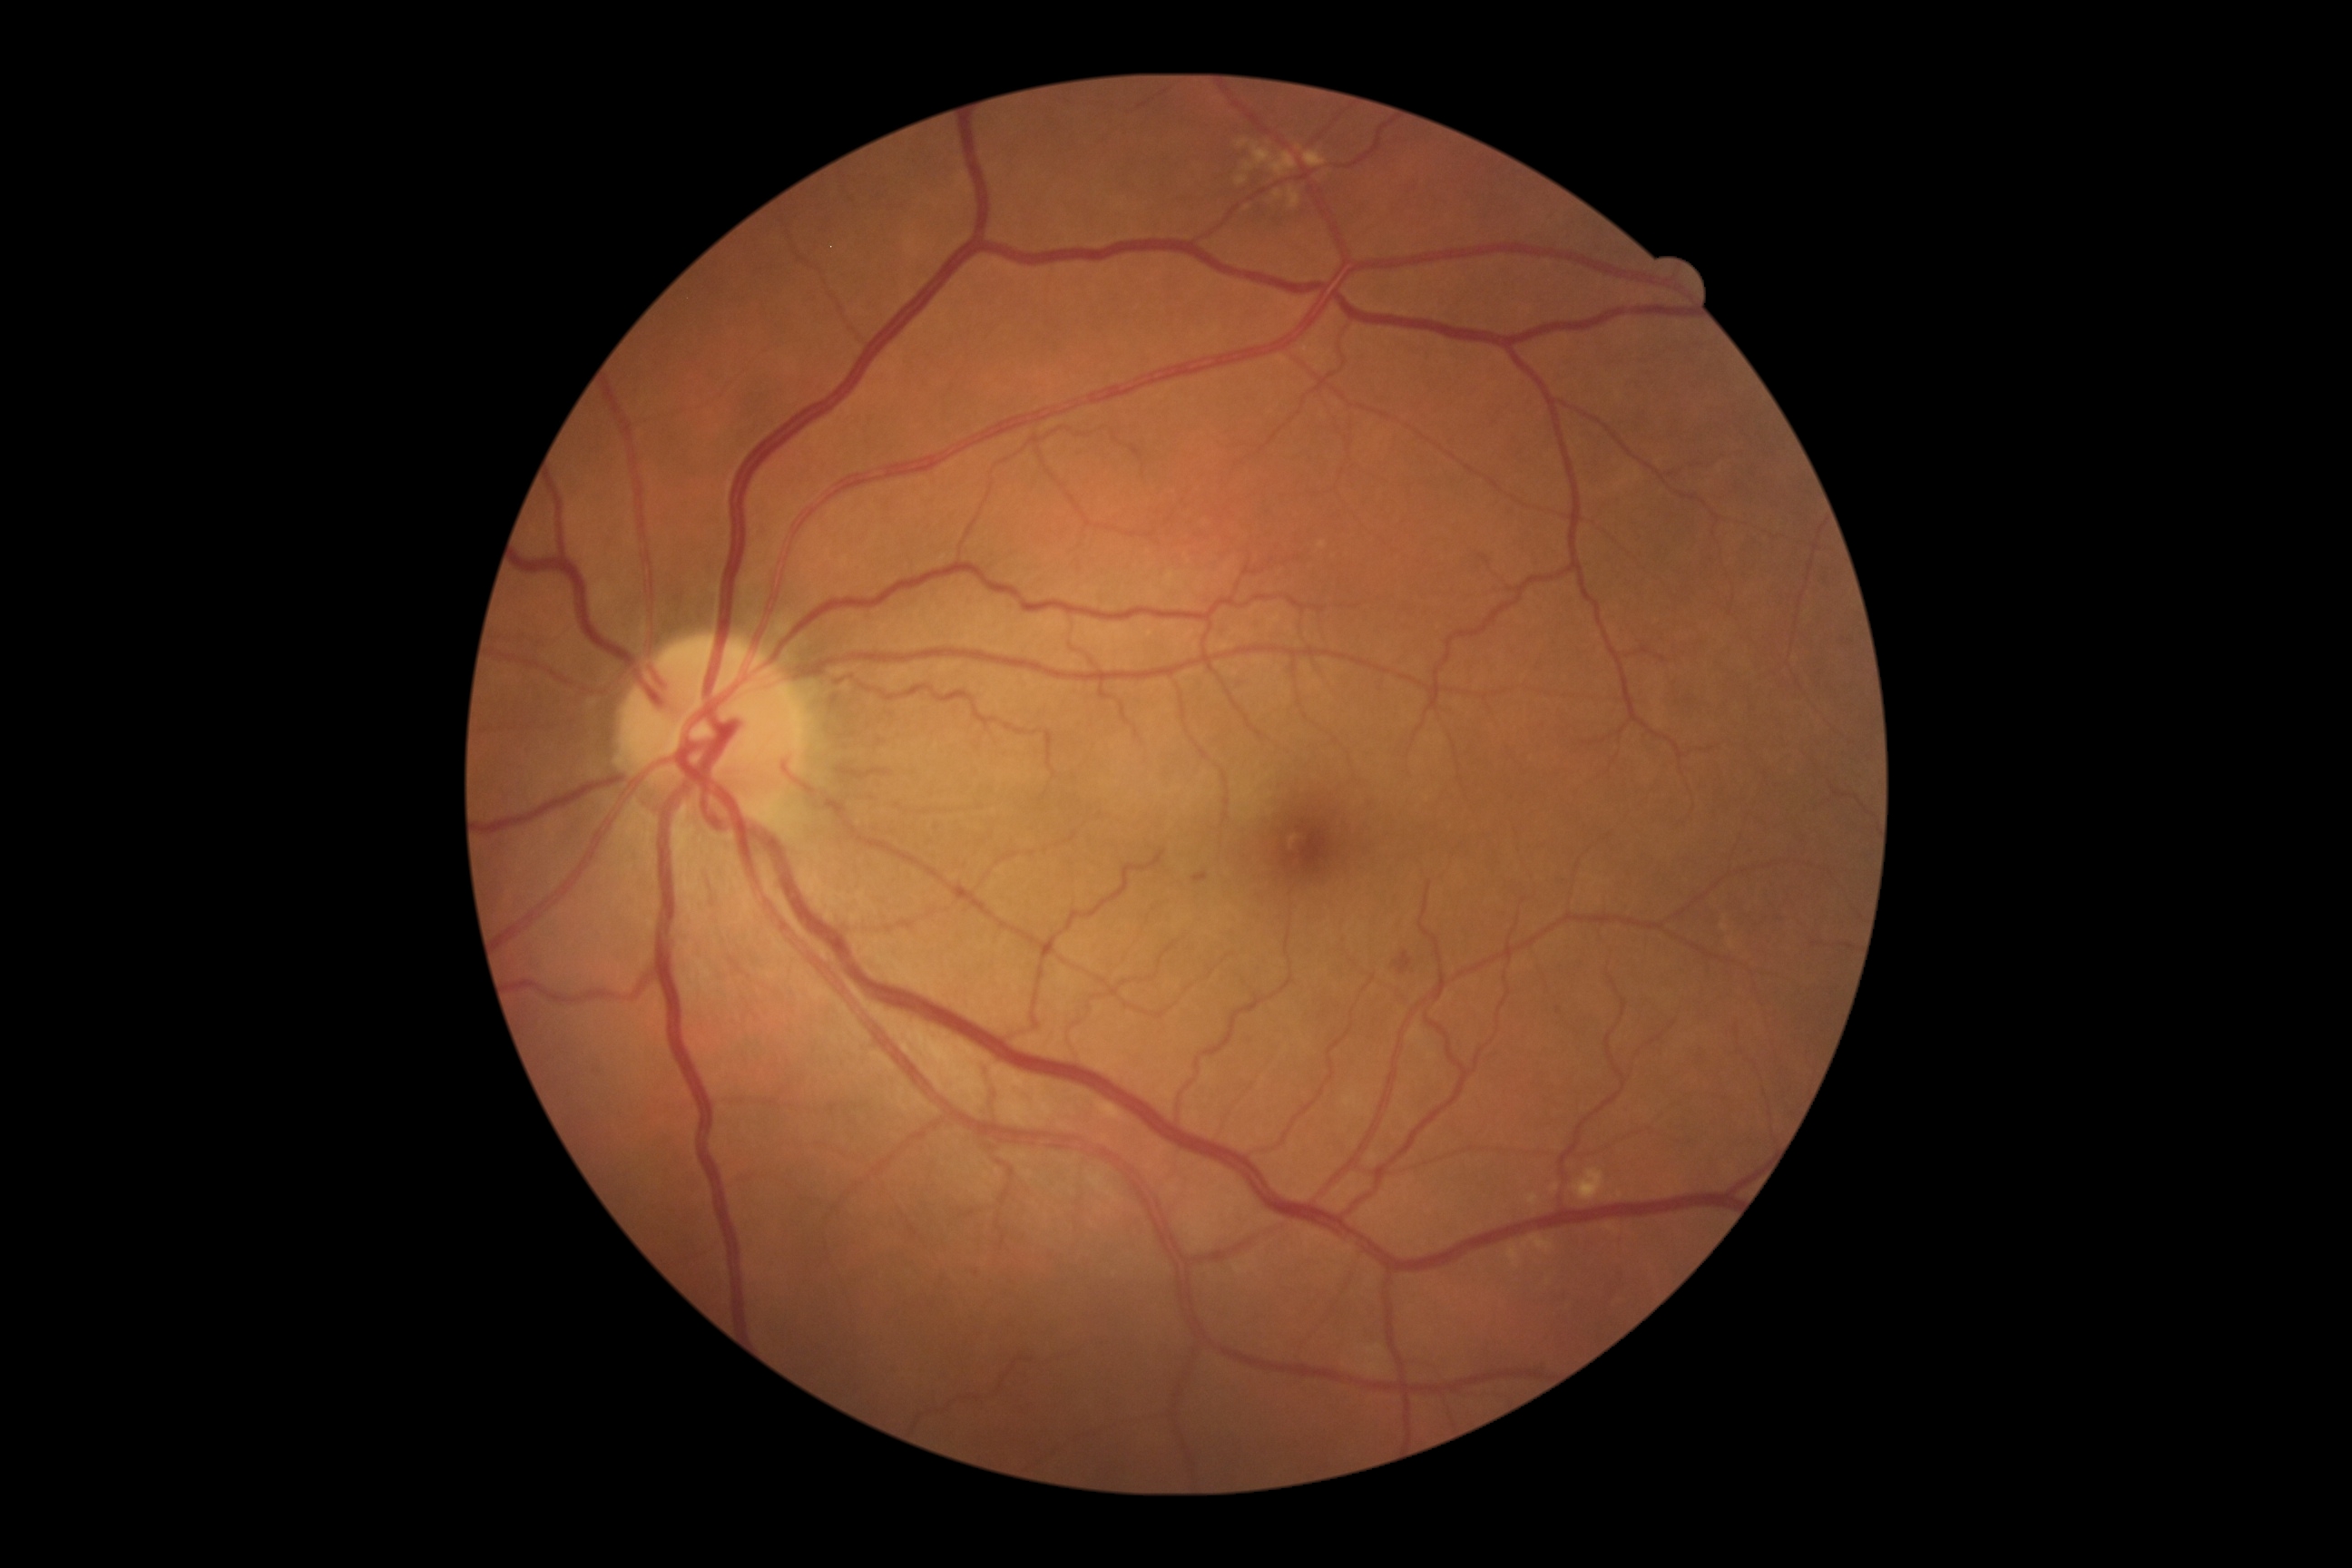 DR stage is grade 2 (moderate NPDR)
EXs = absent
SEs = absent
HEs = BBox(1193, 872, 1208, 885) | BBox(1395, 952, 1413, 974)
MAs = BBox(966, 1264, 979, 1275)